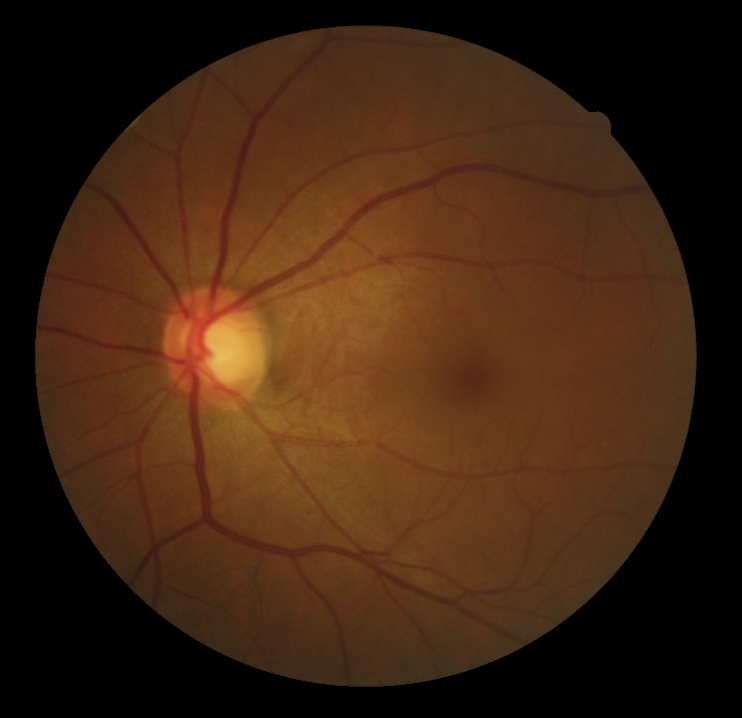

dr_grade: 0/4 — no visible signs of diabetic retinopathy
dr_impression: no signs of DR